45° field of view. 2352 x 1568 pixels. Color fundus image — 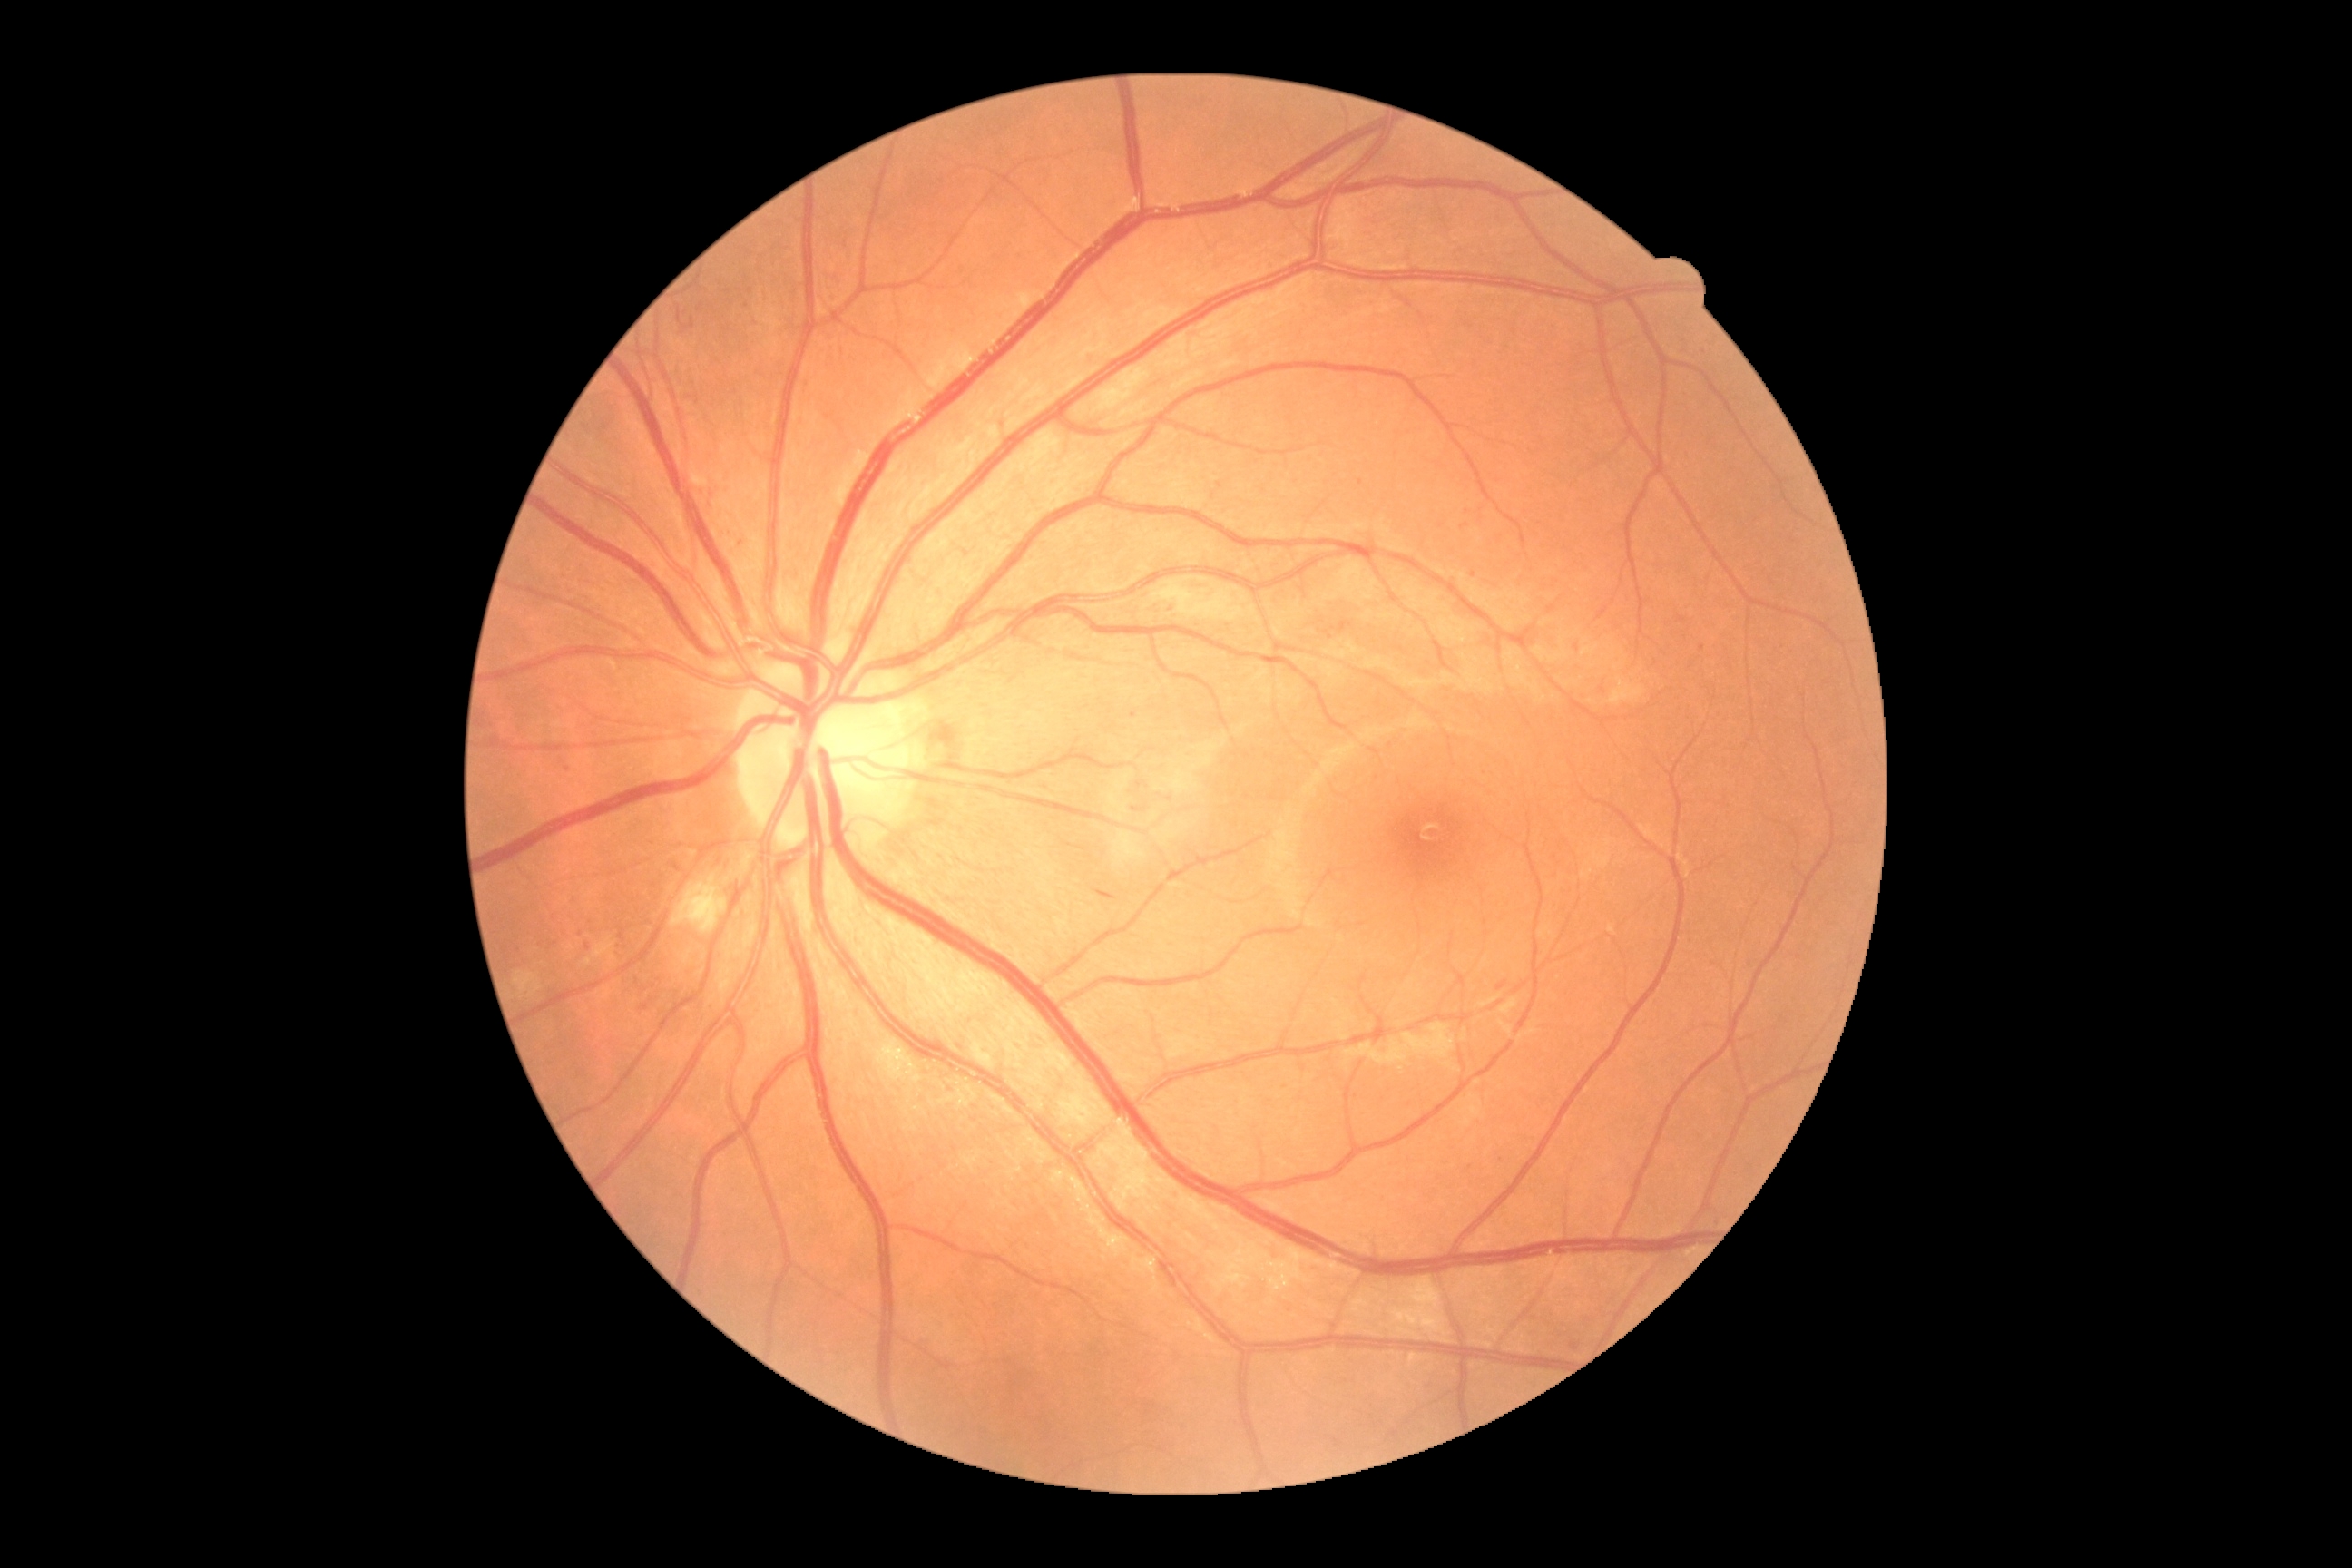

diabetic retinopathy (DR)=grade 2 (moderate NPDR).